Optic disc-centered crop from a color fundus photograph, Topcon TRC fundus camera — 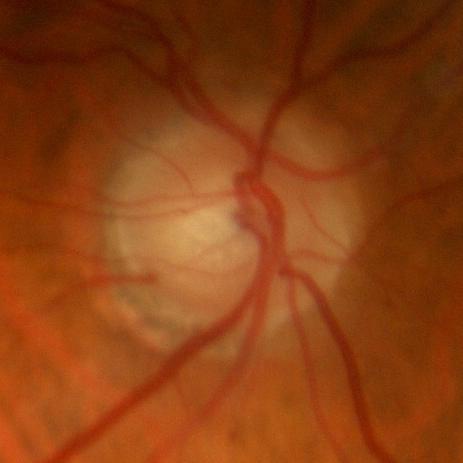 Glaucoma status: no glaucomatous findings.